Camera: NIDEK AFC-230; Davis DR grading; 848x848px; without pupil dilation
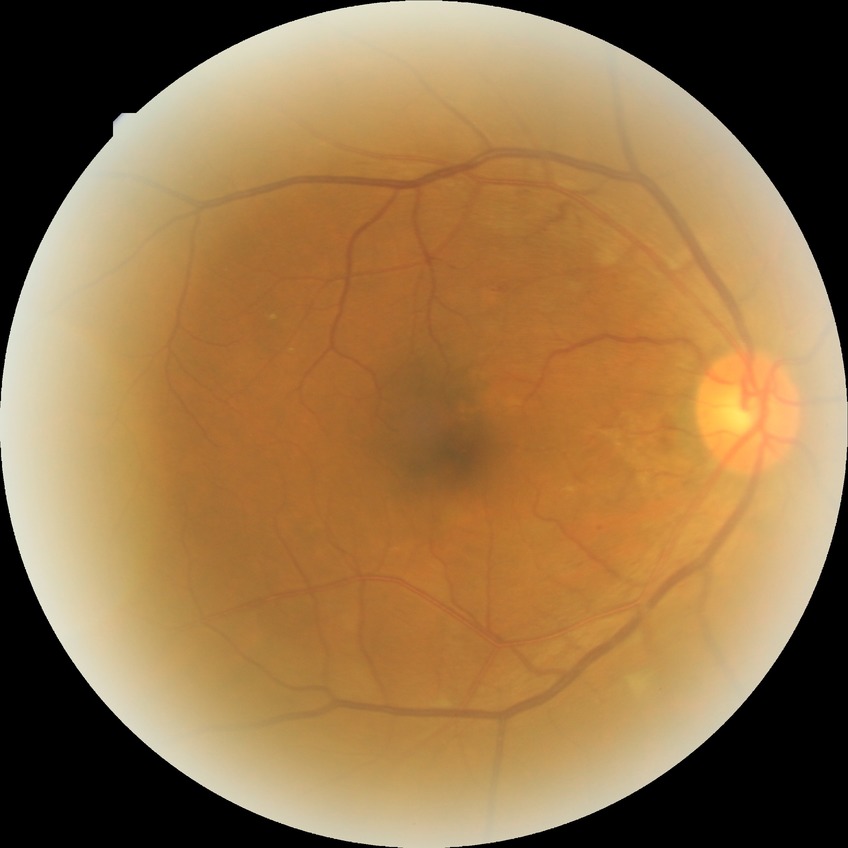

DR class: non-proliferative diabetic retinopathy; diabetic retinopathy (DR): SDR (simple diabetic retinopathy).